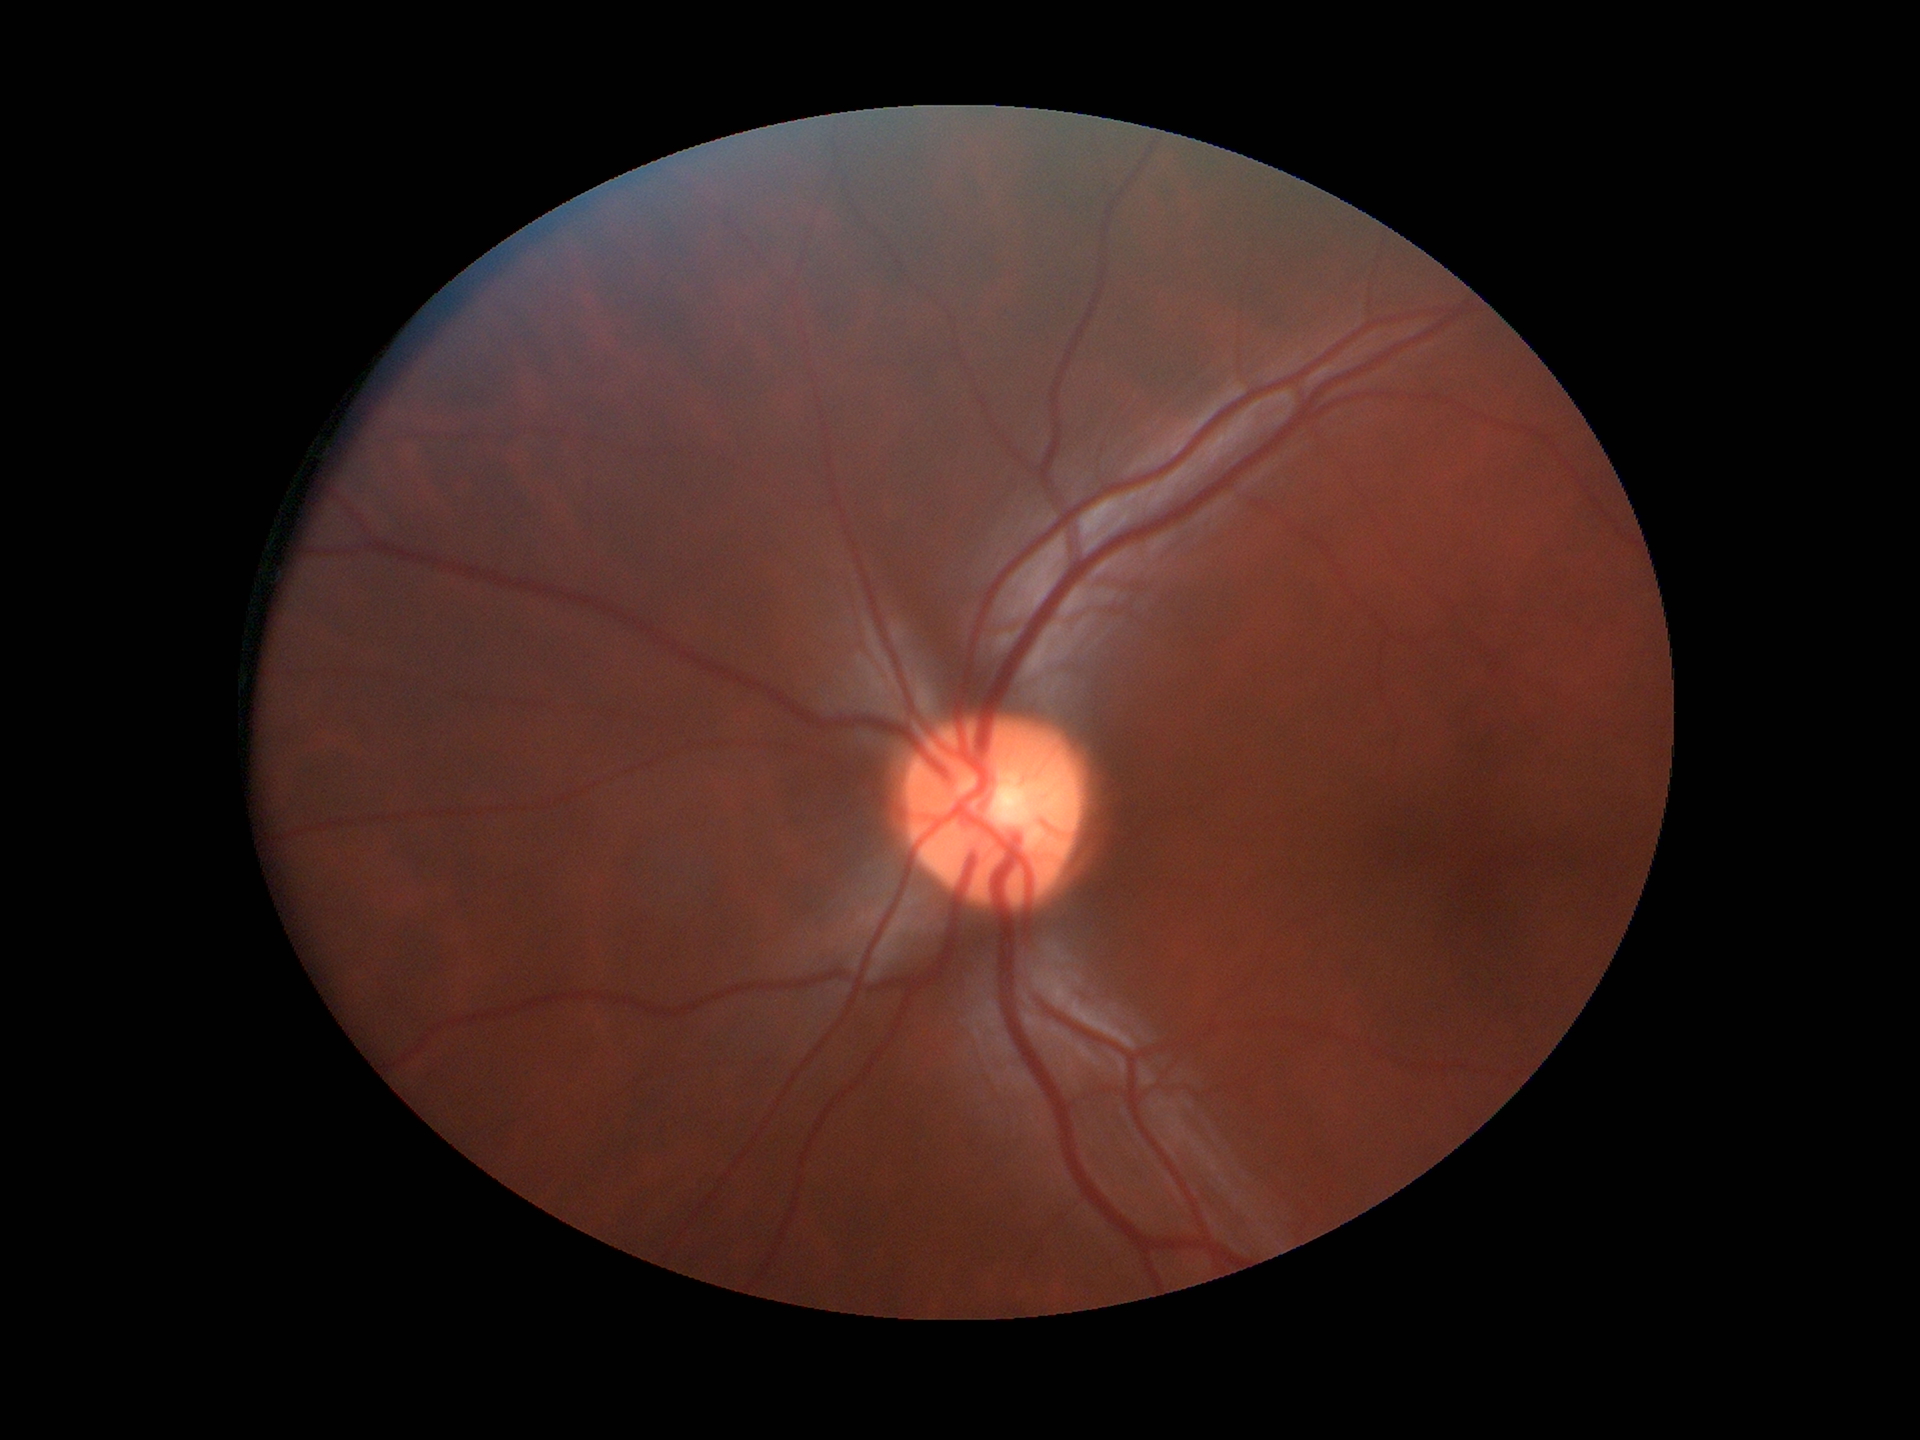
Q: Is there glaucoma suspicion?
A: not suspect
Q: Vertical CDR?
A: 0.48